Fundus photo:
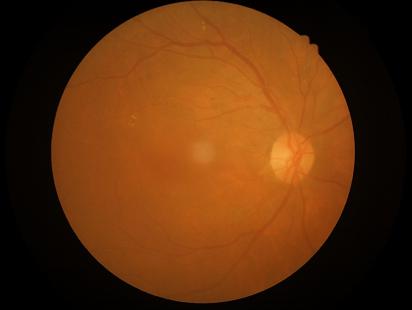 Out of focus; structures are indistinct. Overall quality is good and the image is gradable. Contrast is good. Even illumination with no color cast.